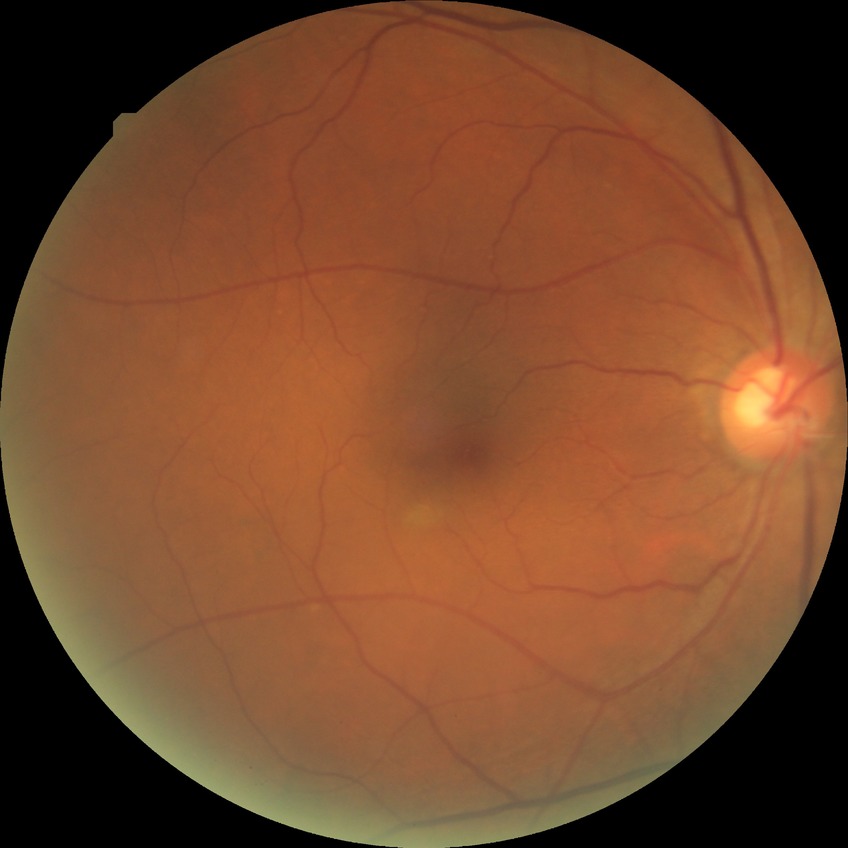 Diabetic retinopathy (DR) is NDR (no diabetic retinopathy).